45 degree fundus photograph. Nonmydriatic fundus photograph. Camera: NIDEK AFC-230.
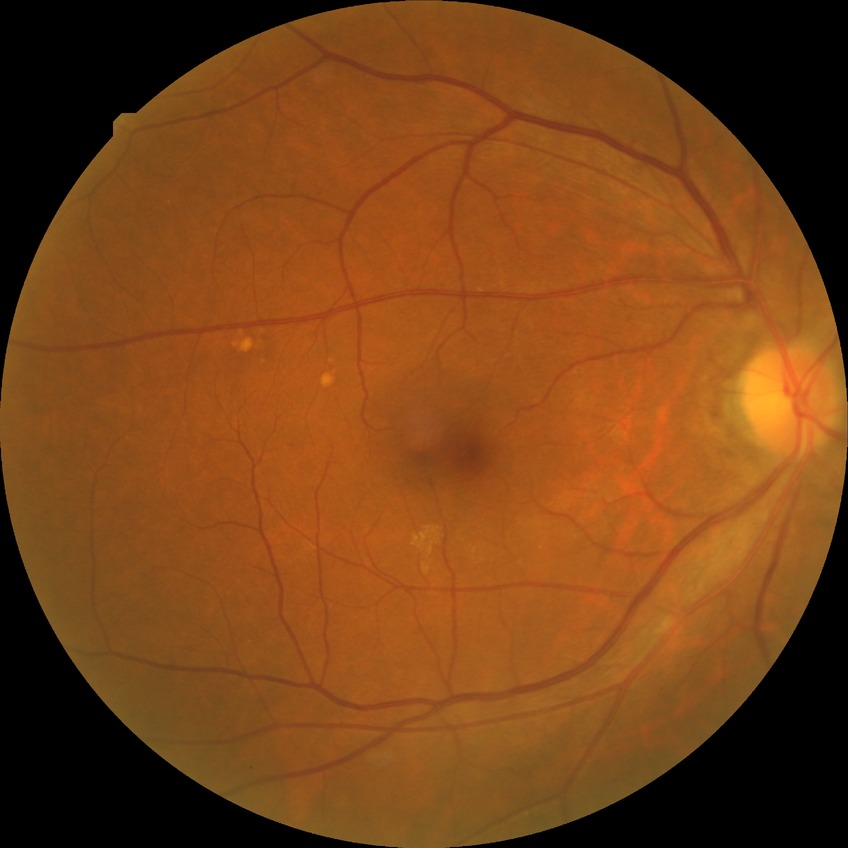
Diabetic retinopathy (DR): NDR (no diabetic retinopathy).